Clarity RetCam 3, 130° FOV; 640 by 480 pixels; wide-field fundus photograph of an infant:
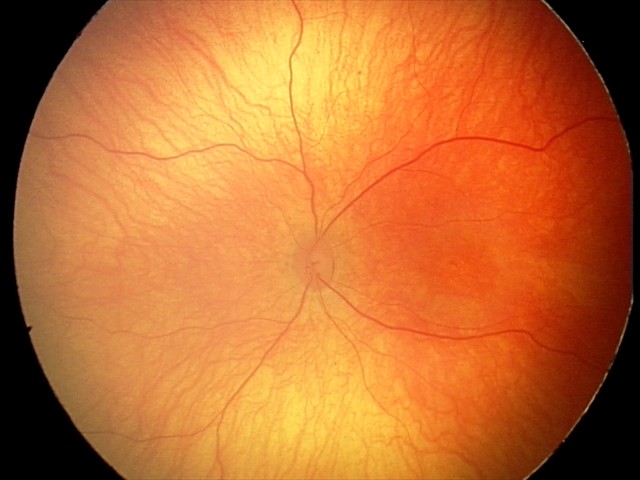 Screening examination with no abnormal retinal findings.